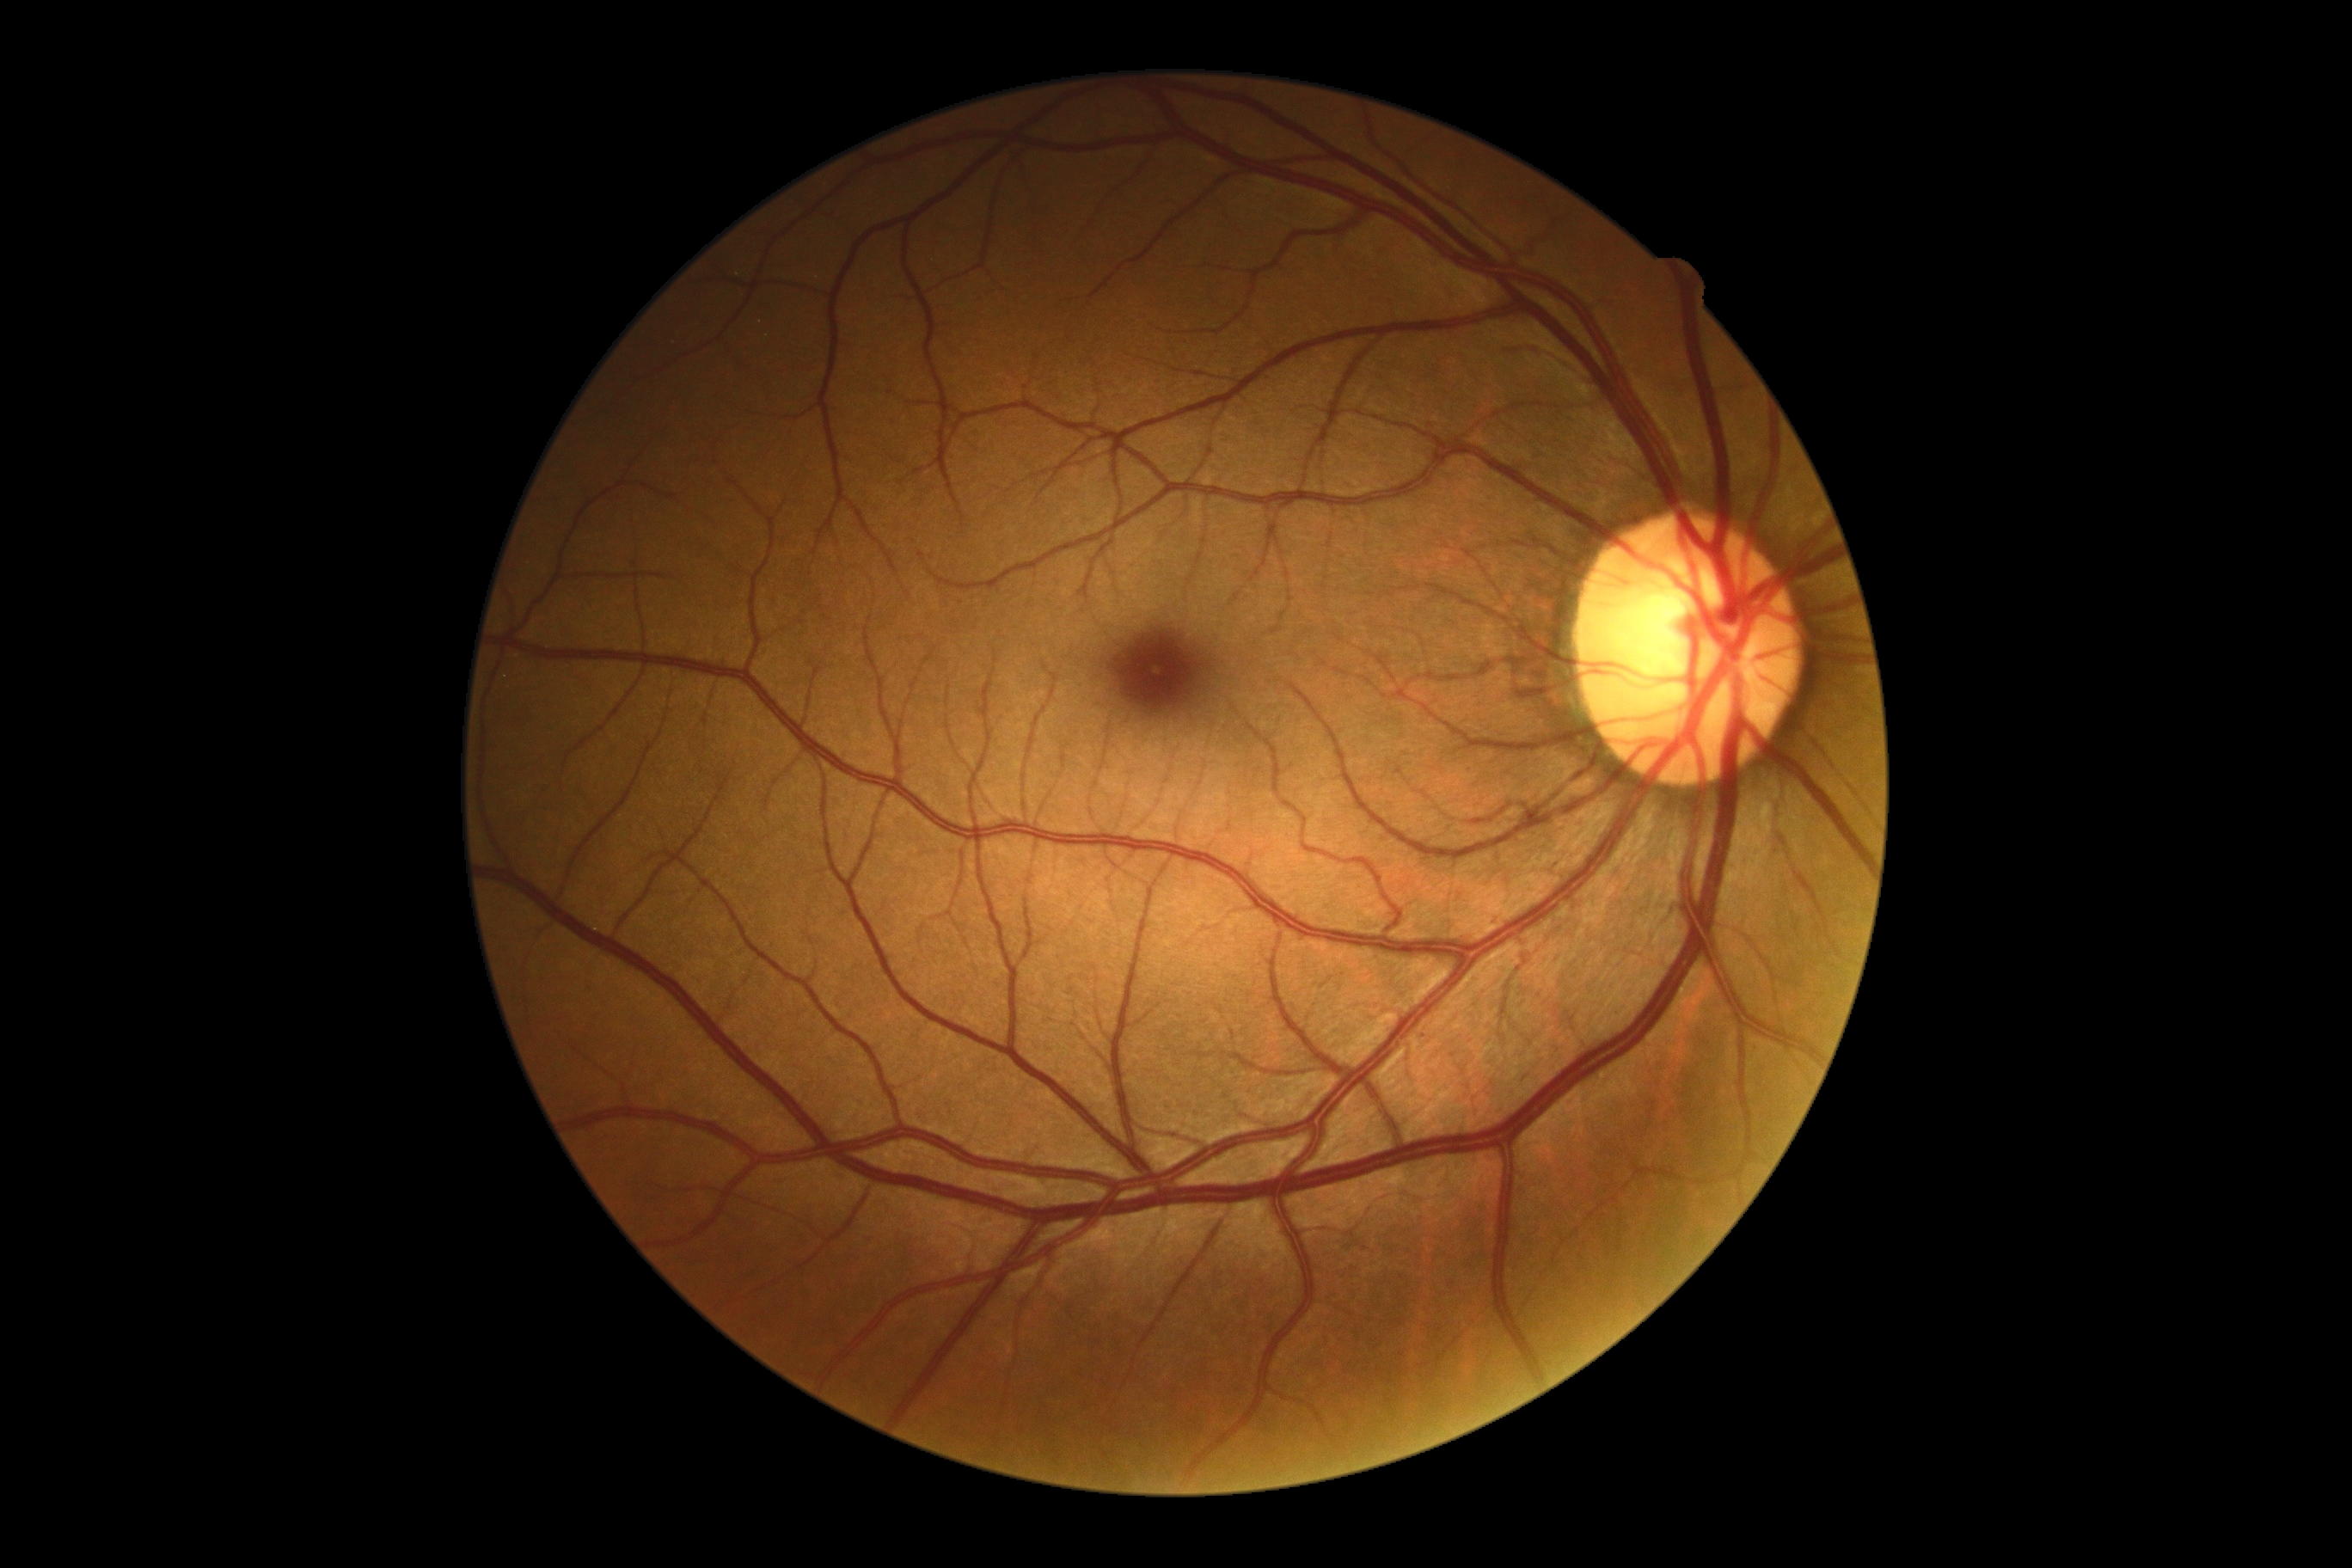

Findings:
- retinopathy grade: no apparent diabetic retinopathy (0) — no visible signs of diabetic retinopathy